848 x 848 pixels; modified Davis classification; color fundus image:
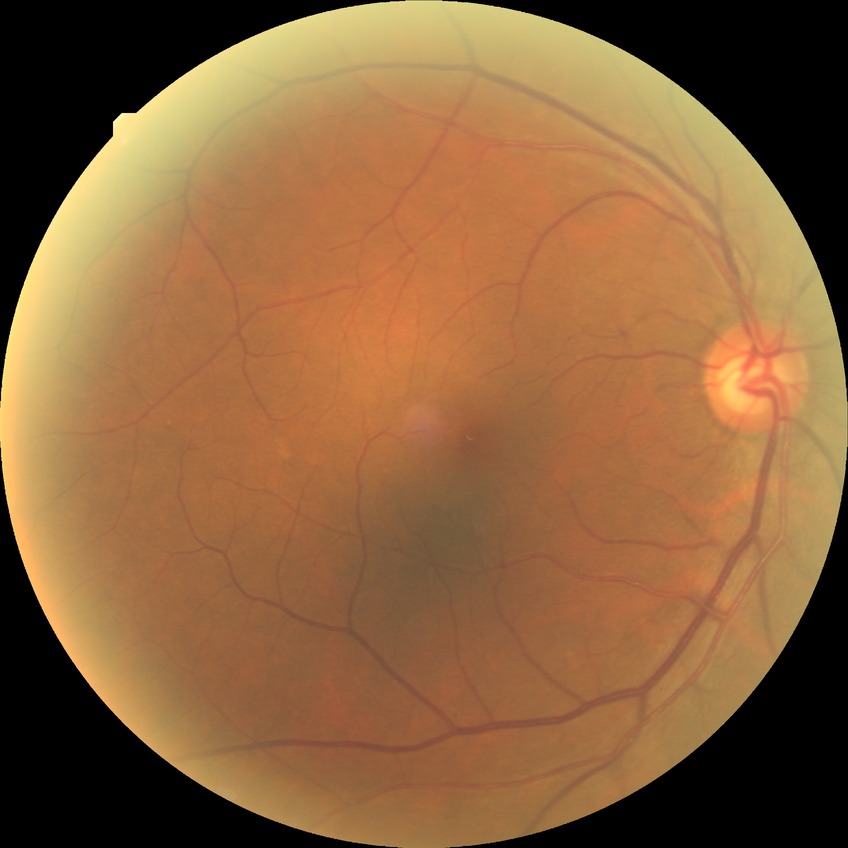 Diabetic retinopathy (DR) is NDR (no diabetic retinopathy).